Posterior pole color fundus photograph · 45° field of view
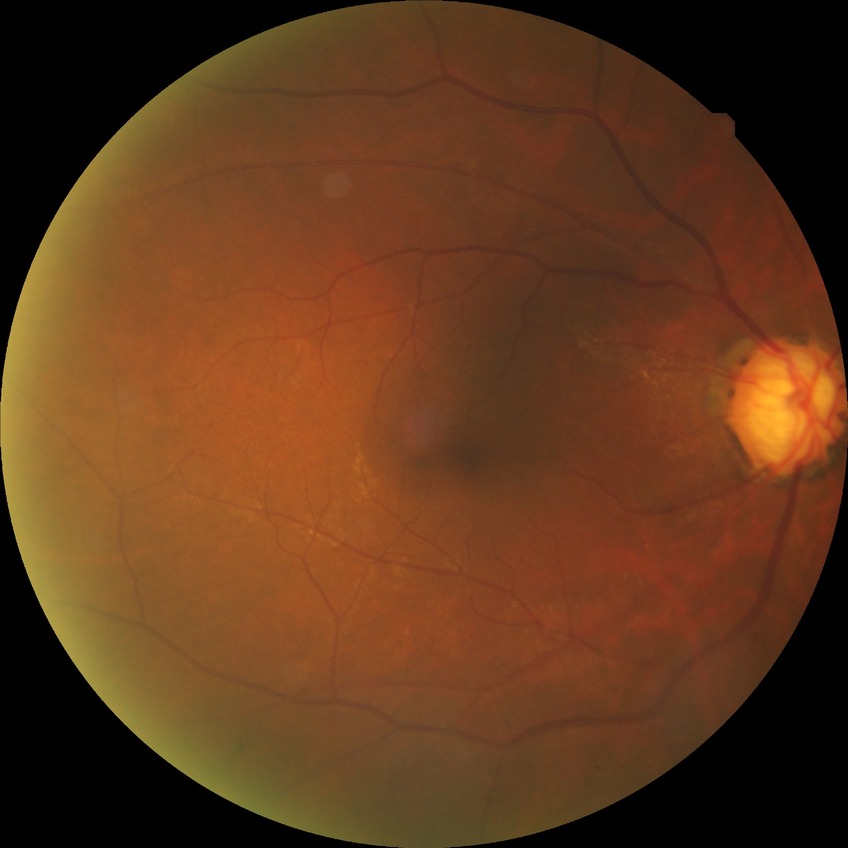

Diabetic retinopathy severity is simple diabetic retinopathy.